Captured with the Clarity RetCam 3 (130° field of view); image size 640x480; wide-field contact fundus photograph of an infant — 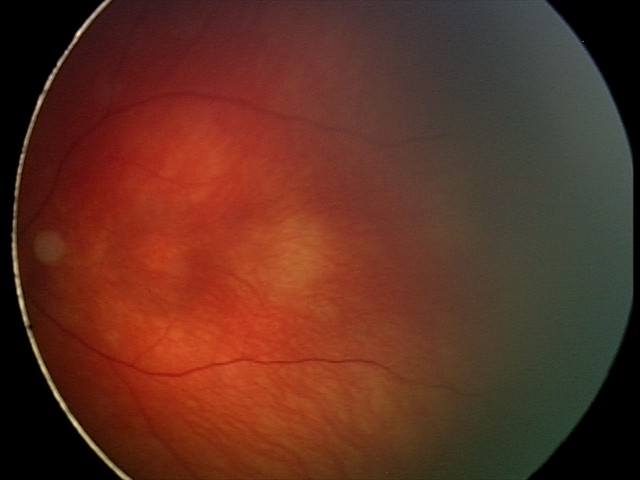 Screening examination consistent with retinal hemorrhages.